Color fundus photograph centered on the optic disc.
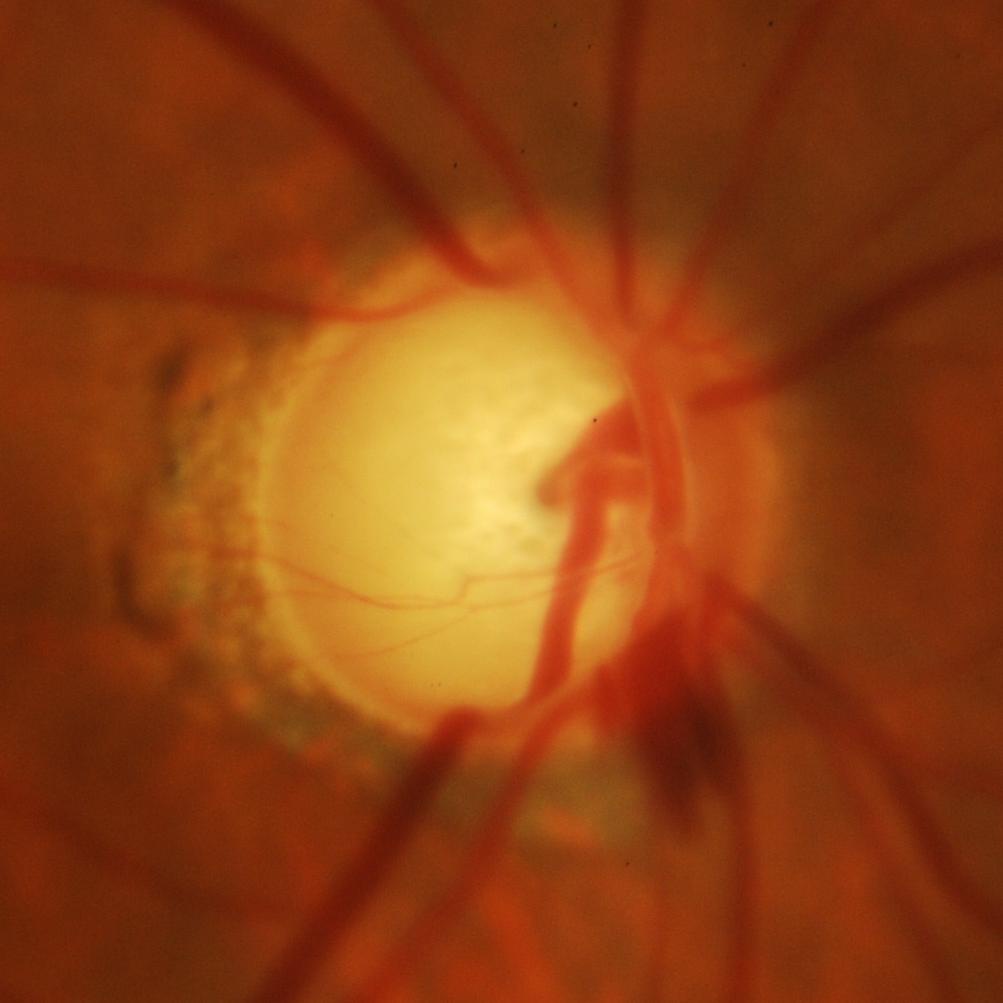

Glaucoma assessment = glaucomatous changes.